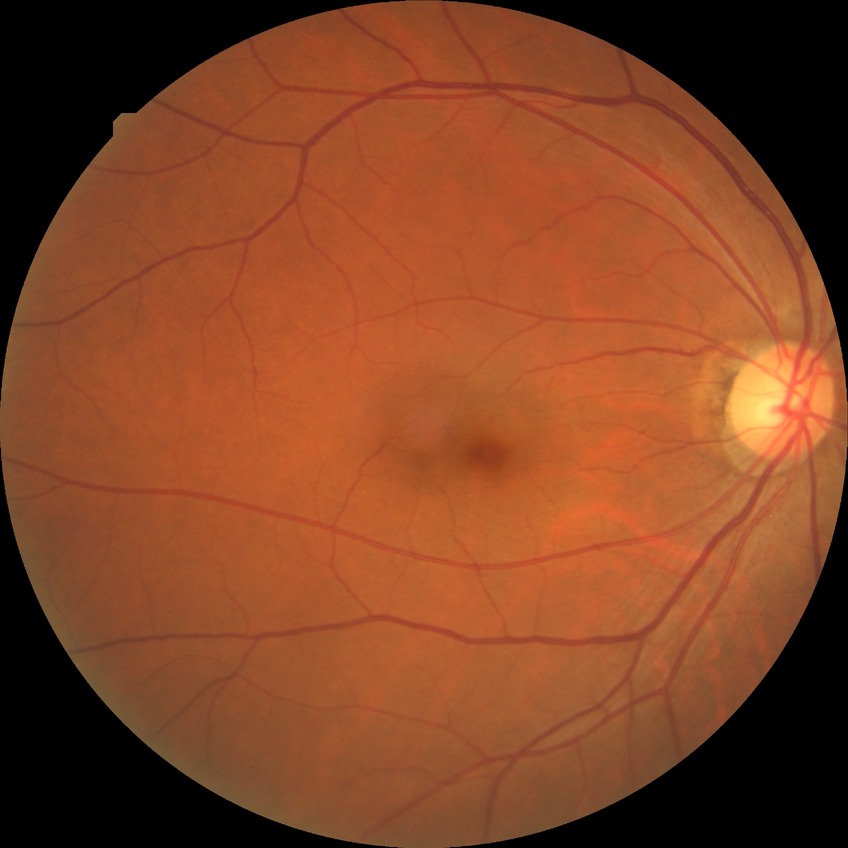 retinopathy stage: no diabetic retinopathy.